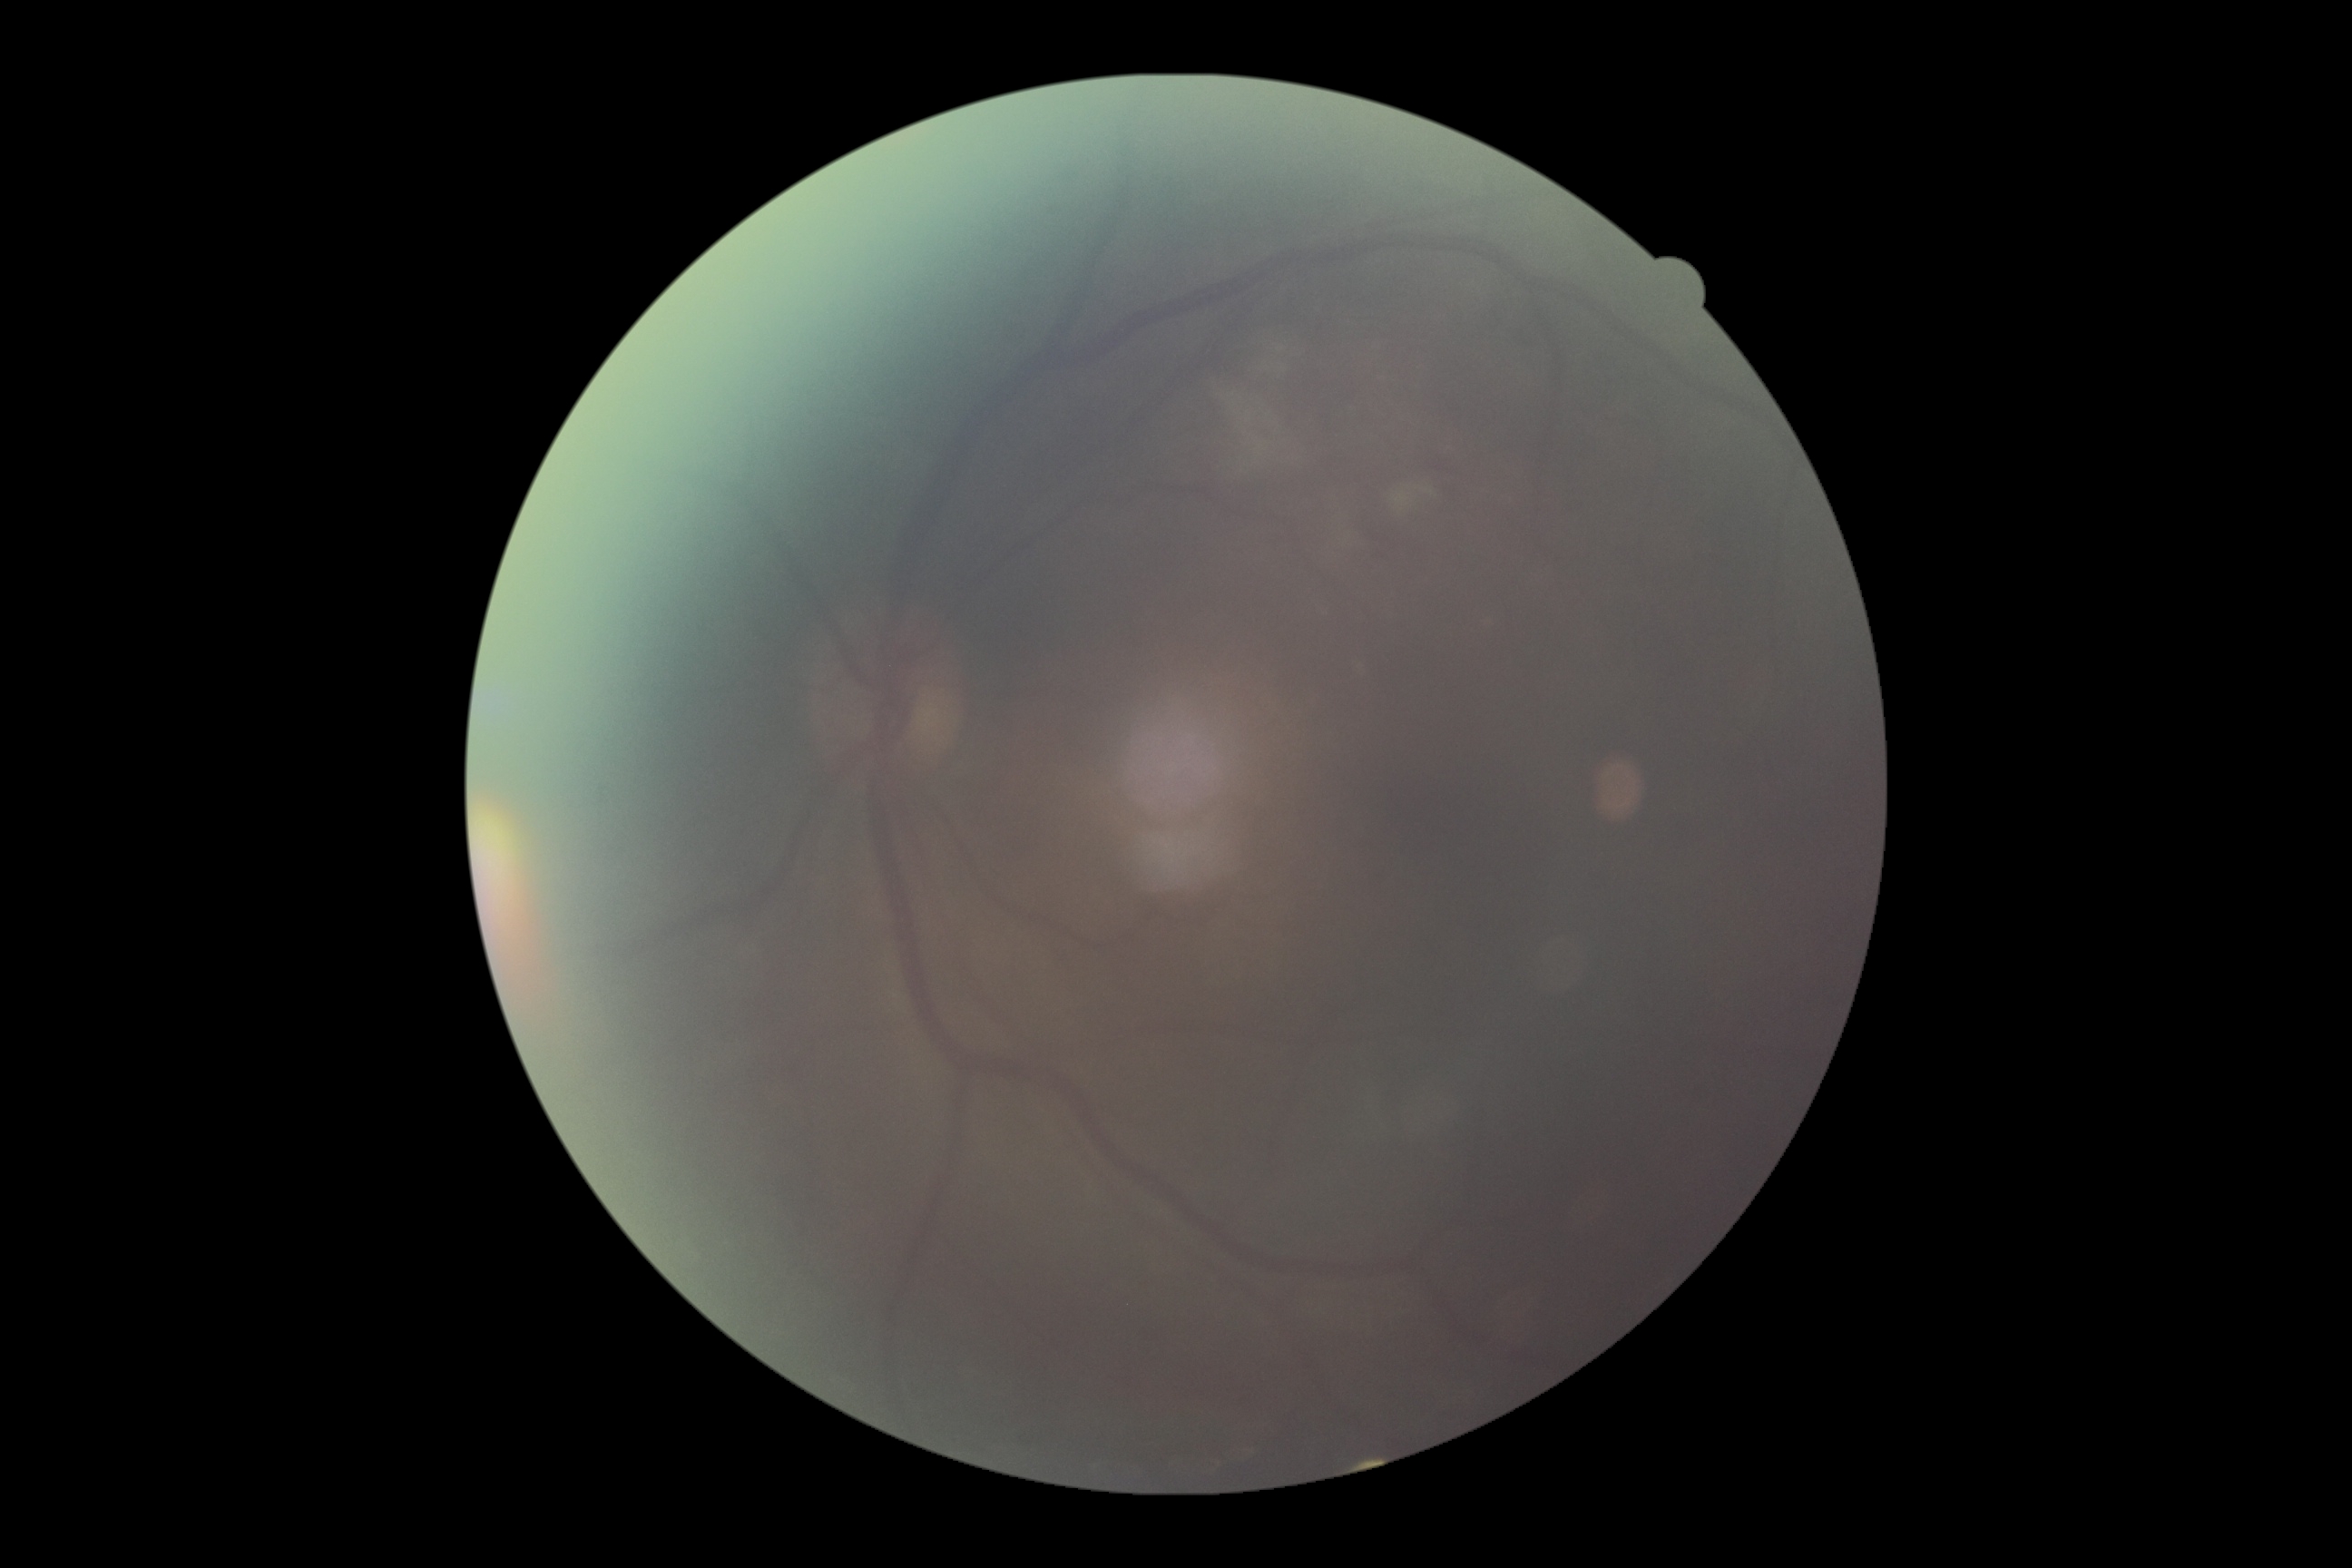 DR severity is ungradable due to poor image quality.